Wide-field contact fundus photograph of an infant · camera: Natus RetCam Envision (130° FOV)
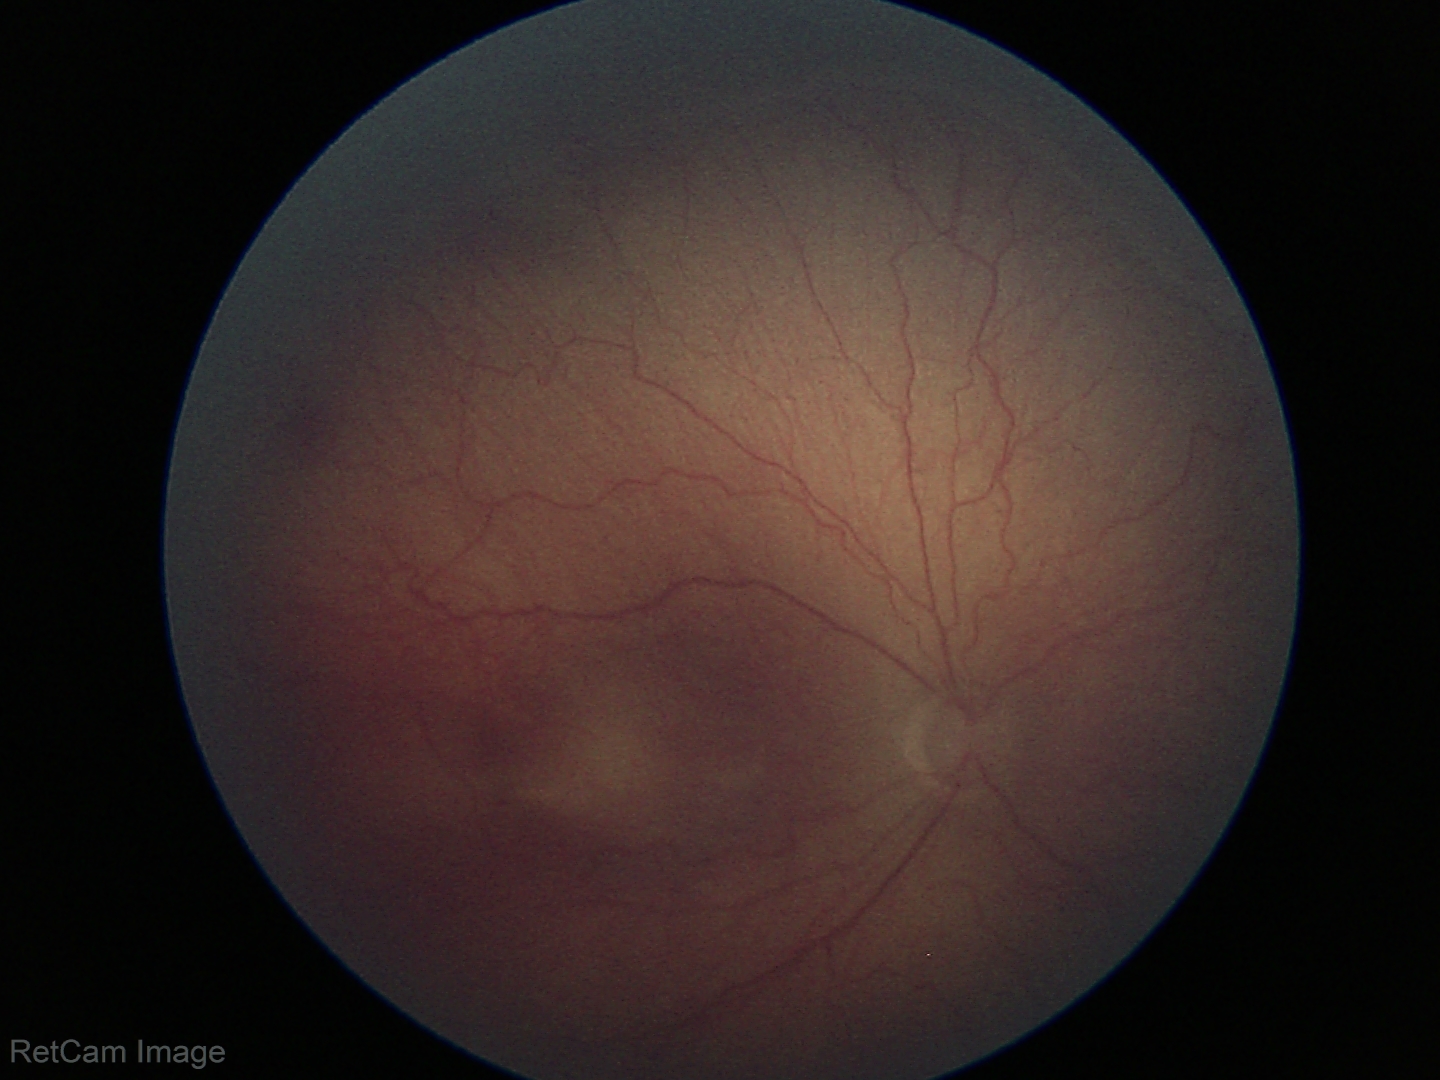 Series diagnosed as retinopathy of prematurity (ROP) stage 2.
Plus disease absent.